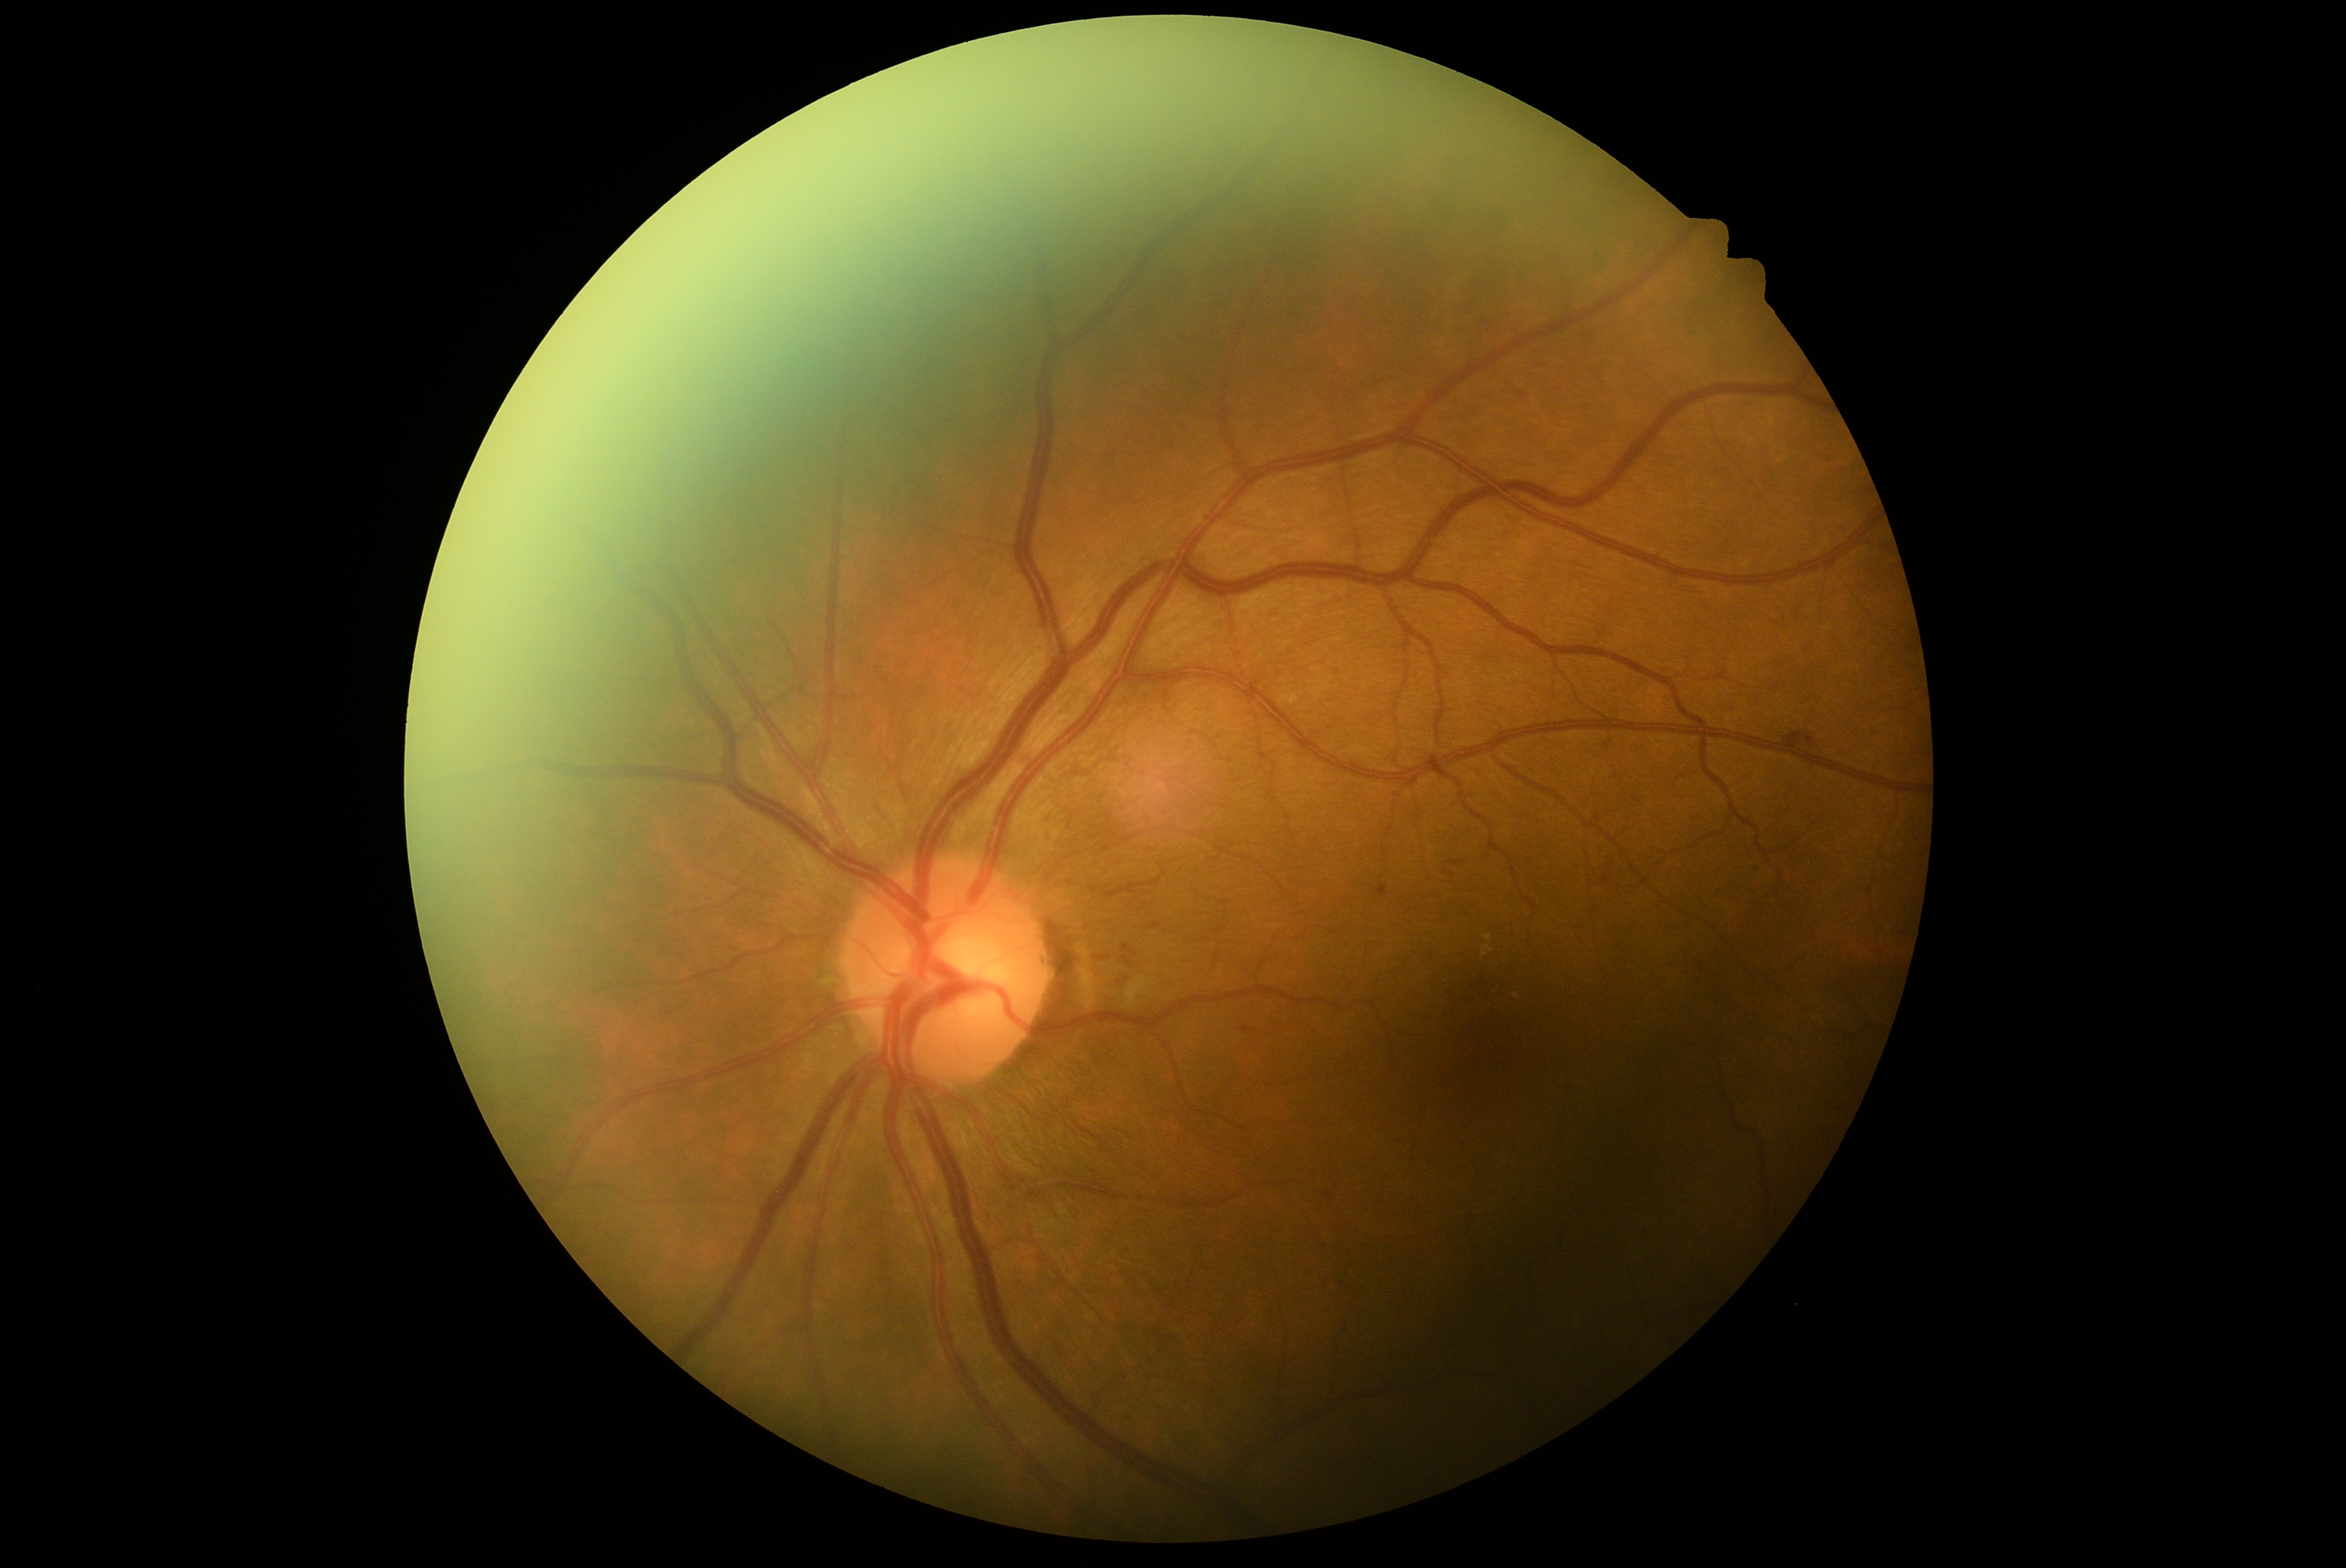 Annotations:
- retinopathy — grade 2 (moderate NPDR)
- DR class — non-proliferative diabetic retinopathy